FOV: 45 degrees · 2352x1568px.
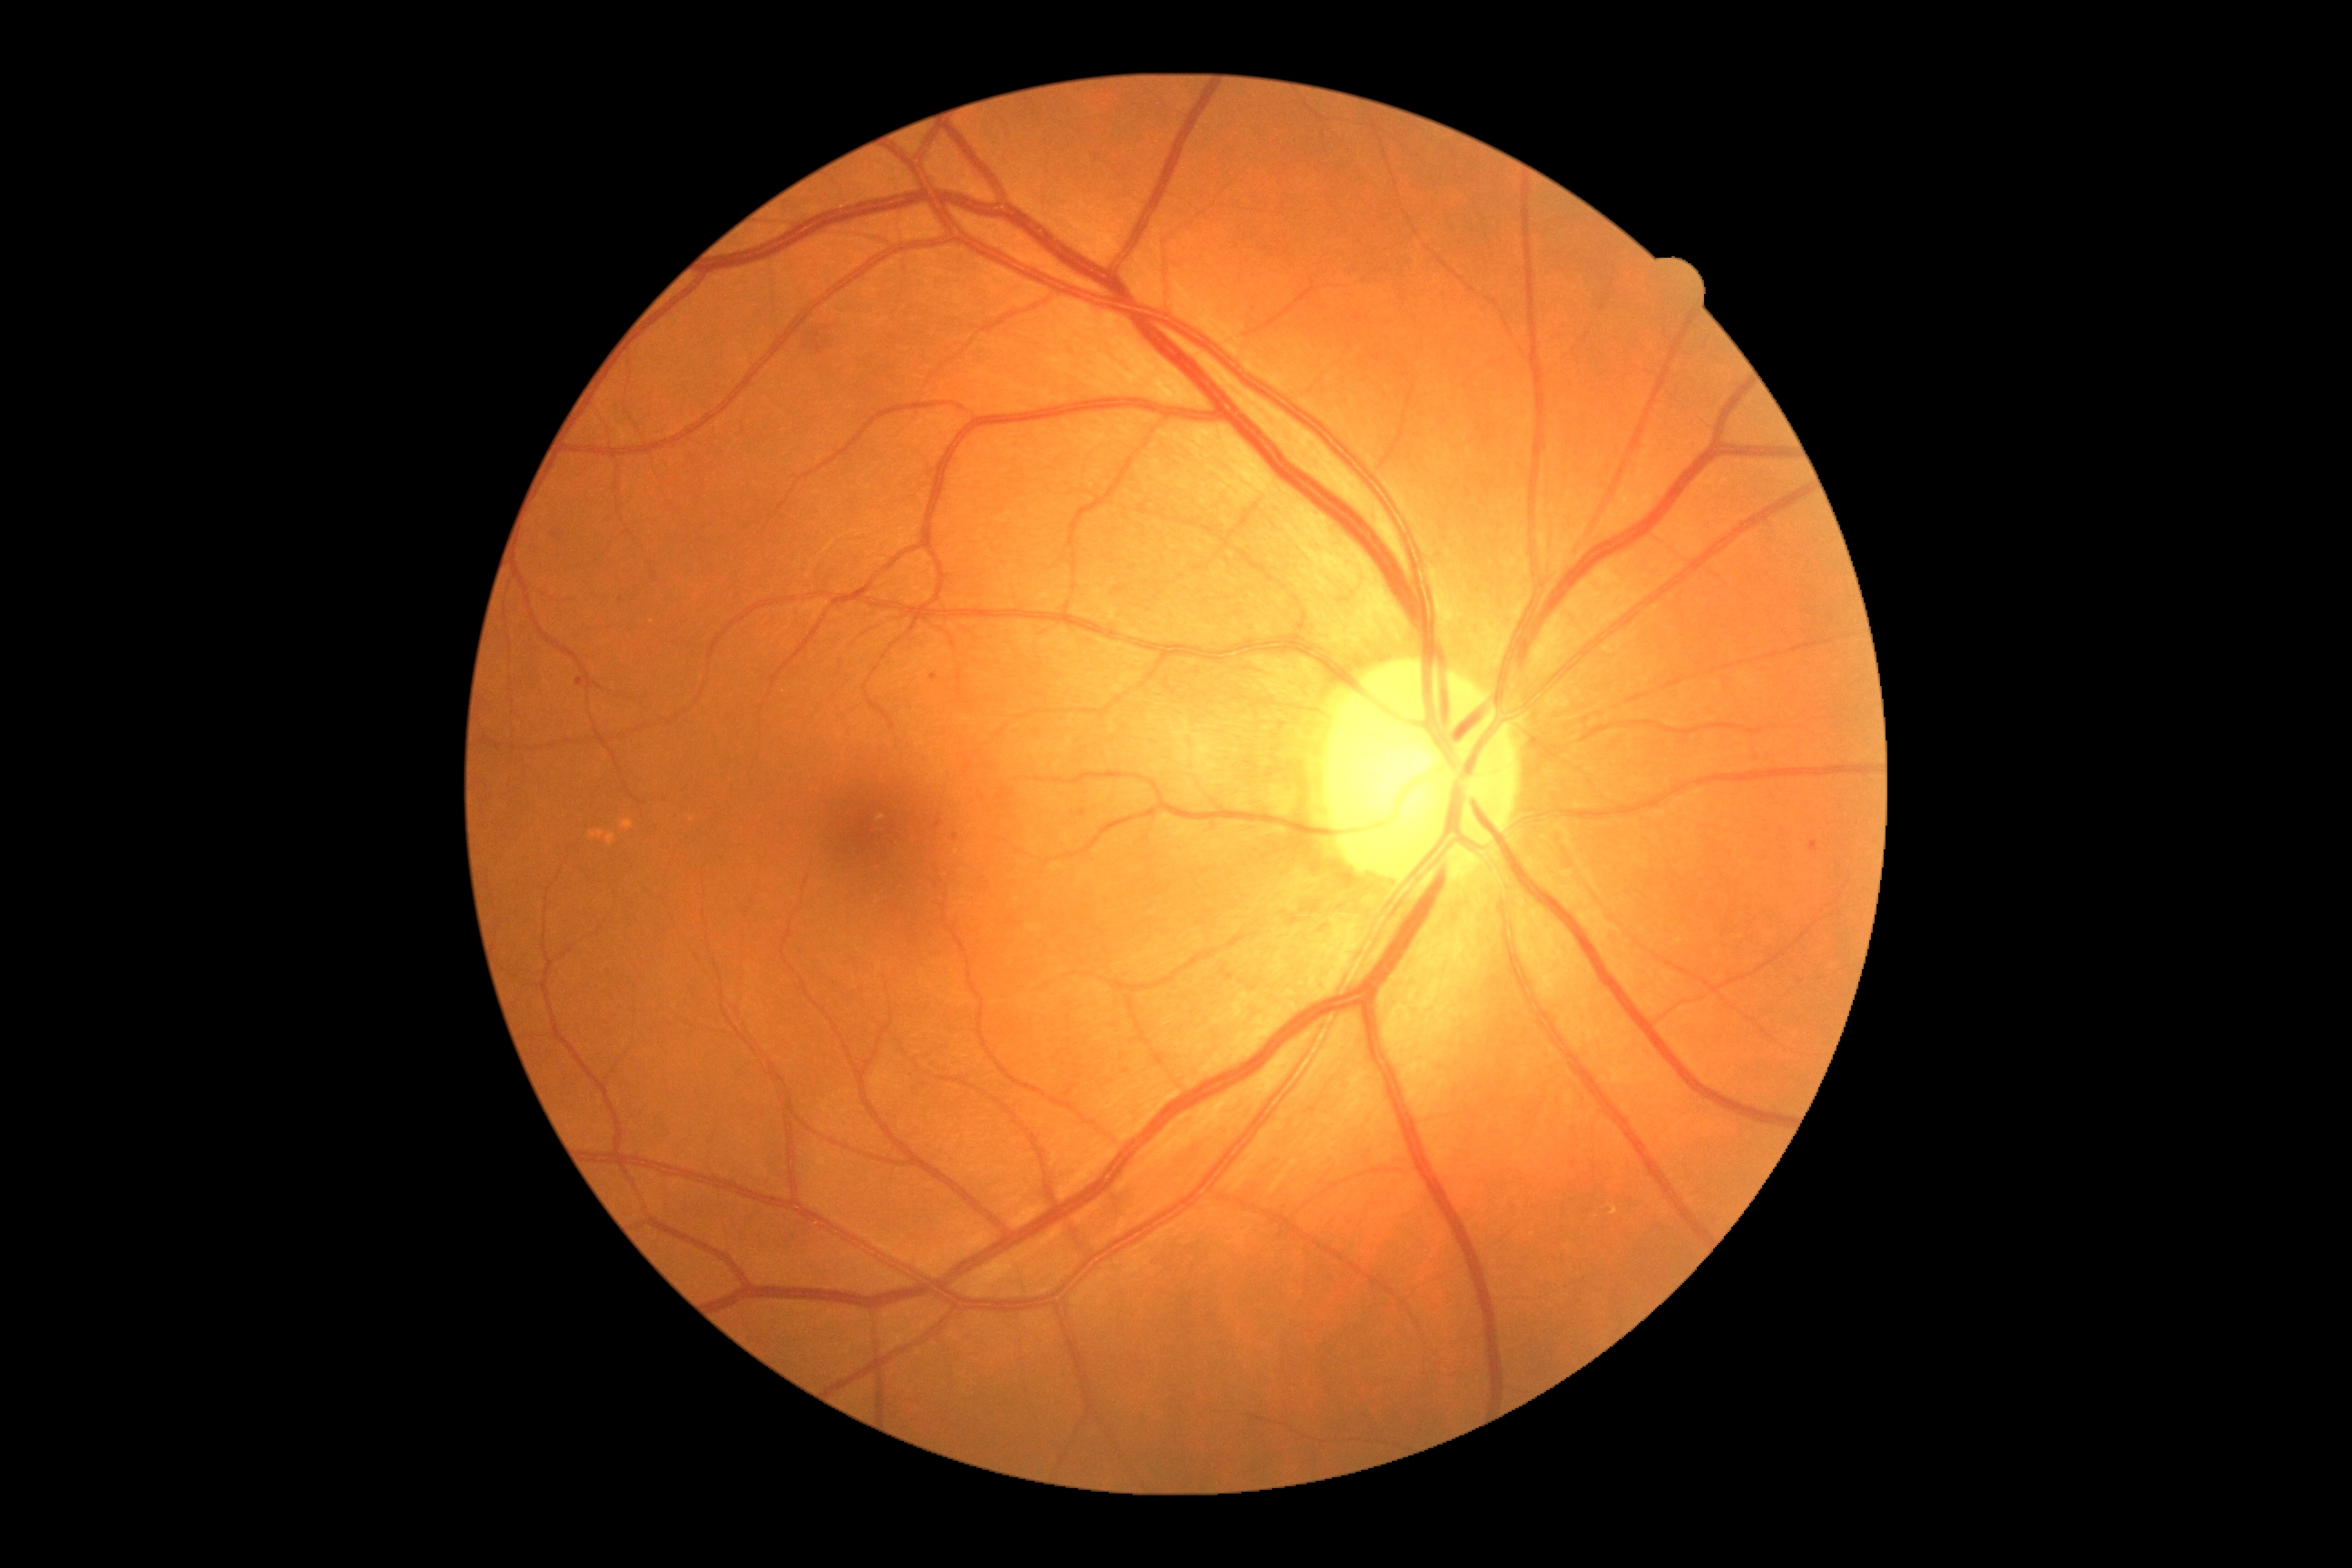
Annotations:
* diabetic retinopathy grade — moderate NPDR (2)